No pharmacologic dilation, modified Davis grading, camera: NIDEK AFC-230: 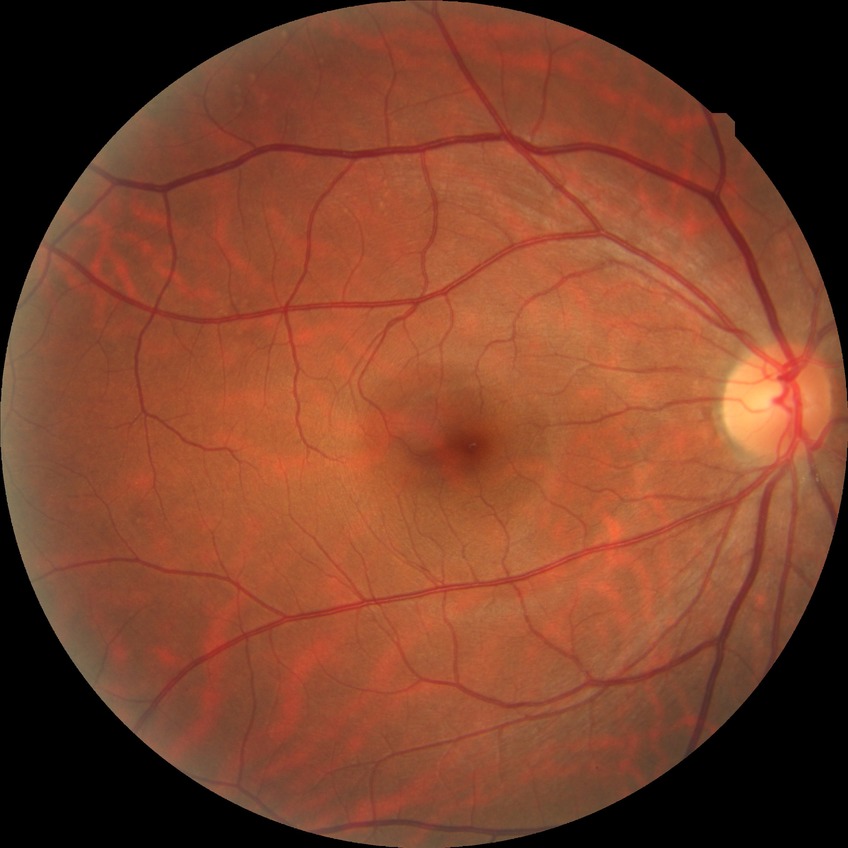
davis_grade: no diabetic retinopathy